NIDEK AFC-230; 45° FOV; 848 x 848 pixels
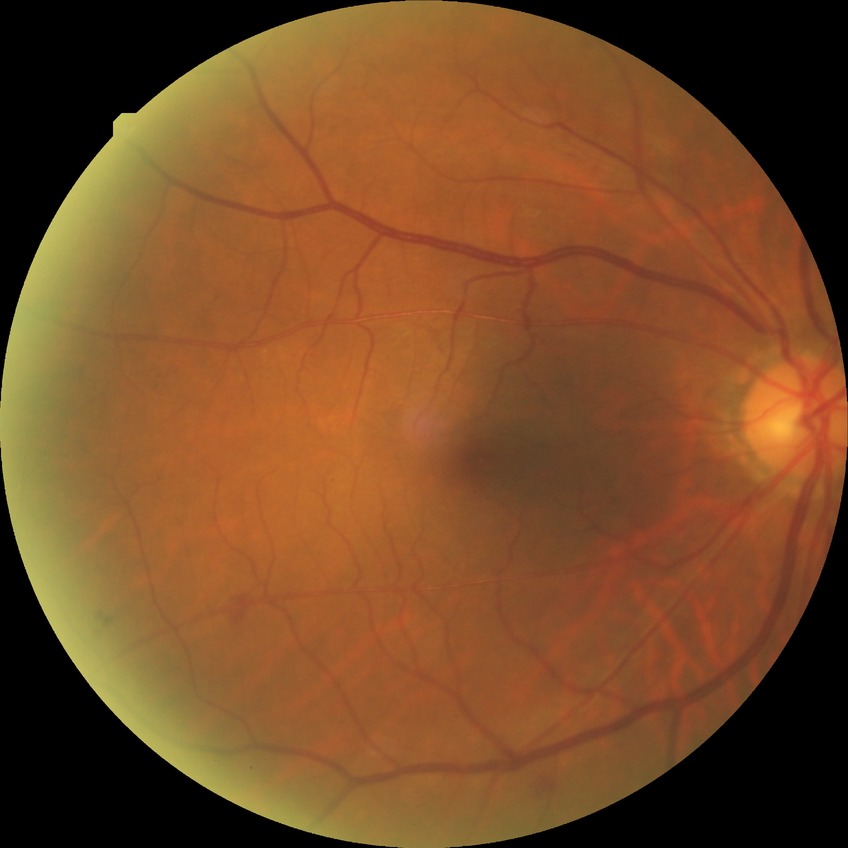 diabetic retinopathy (DR) = SDR (simple diabetic retinopathy).